848 x 848 pixels, posterior pole color fundus photograph:
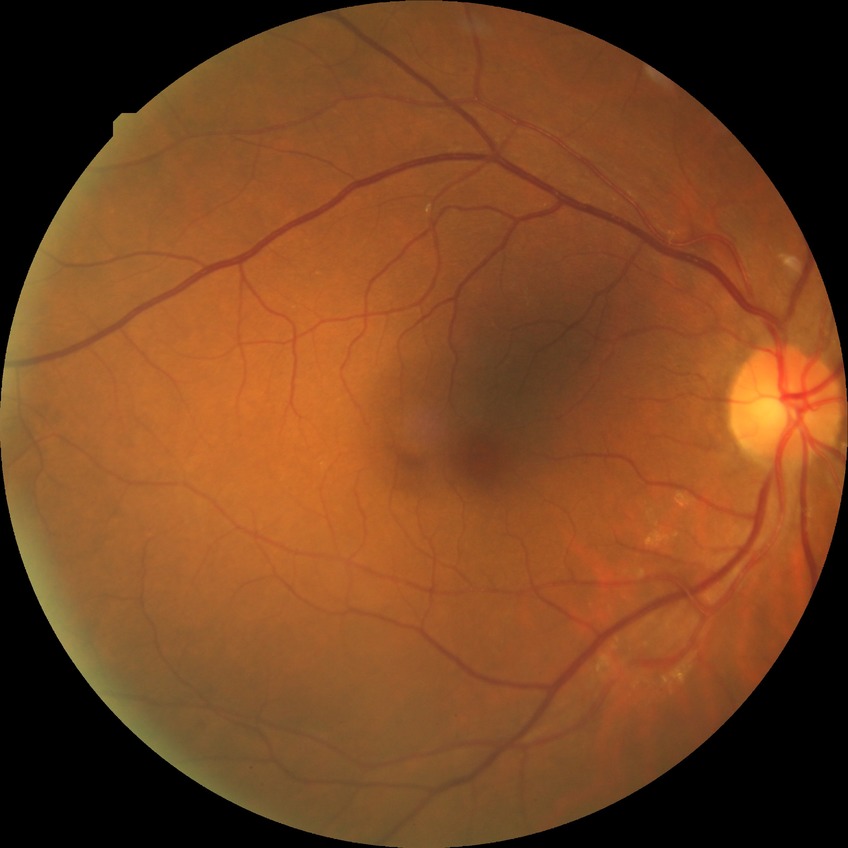

DR = NDR.